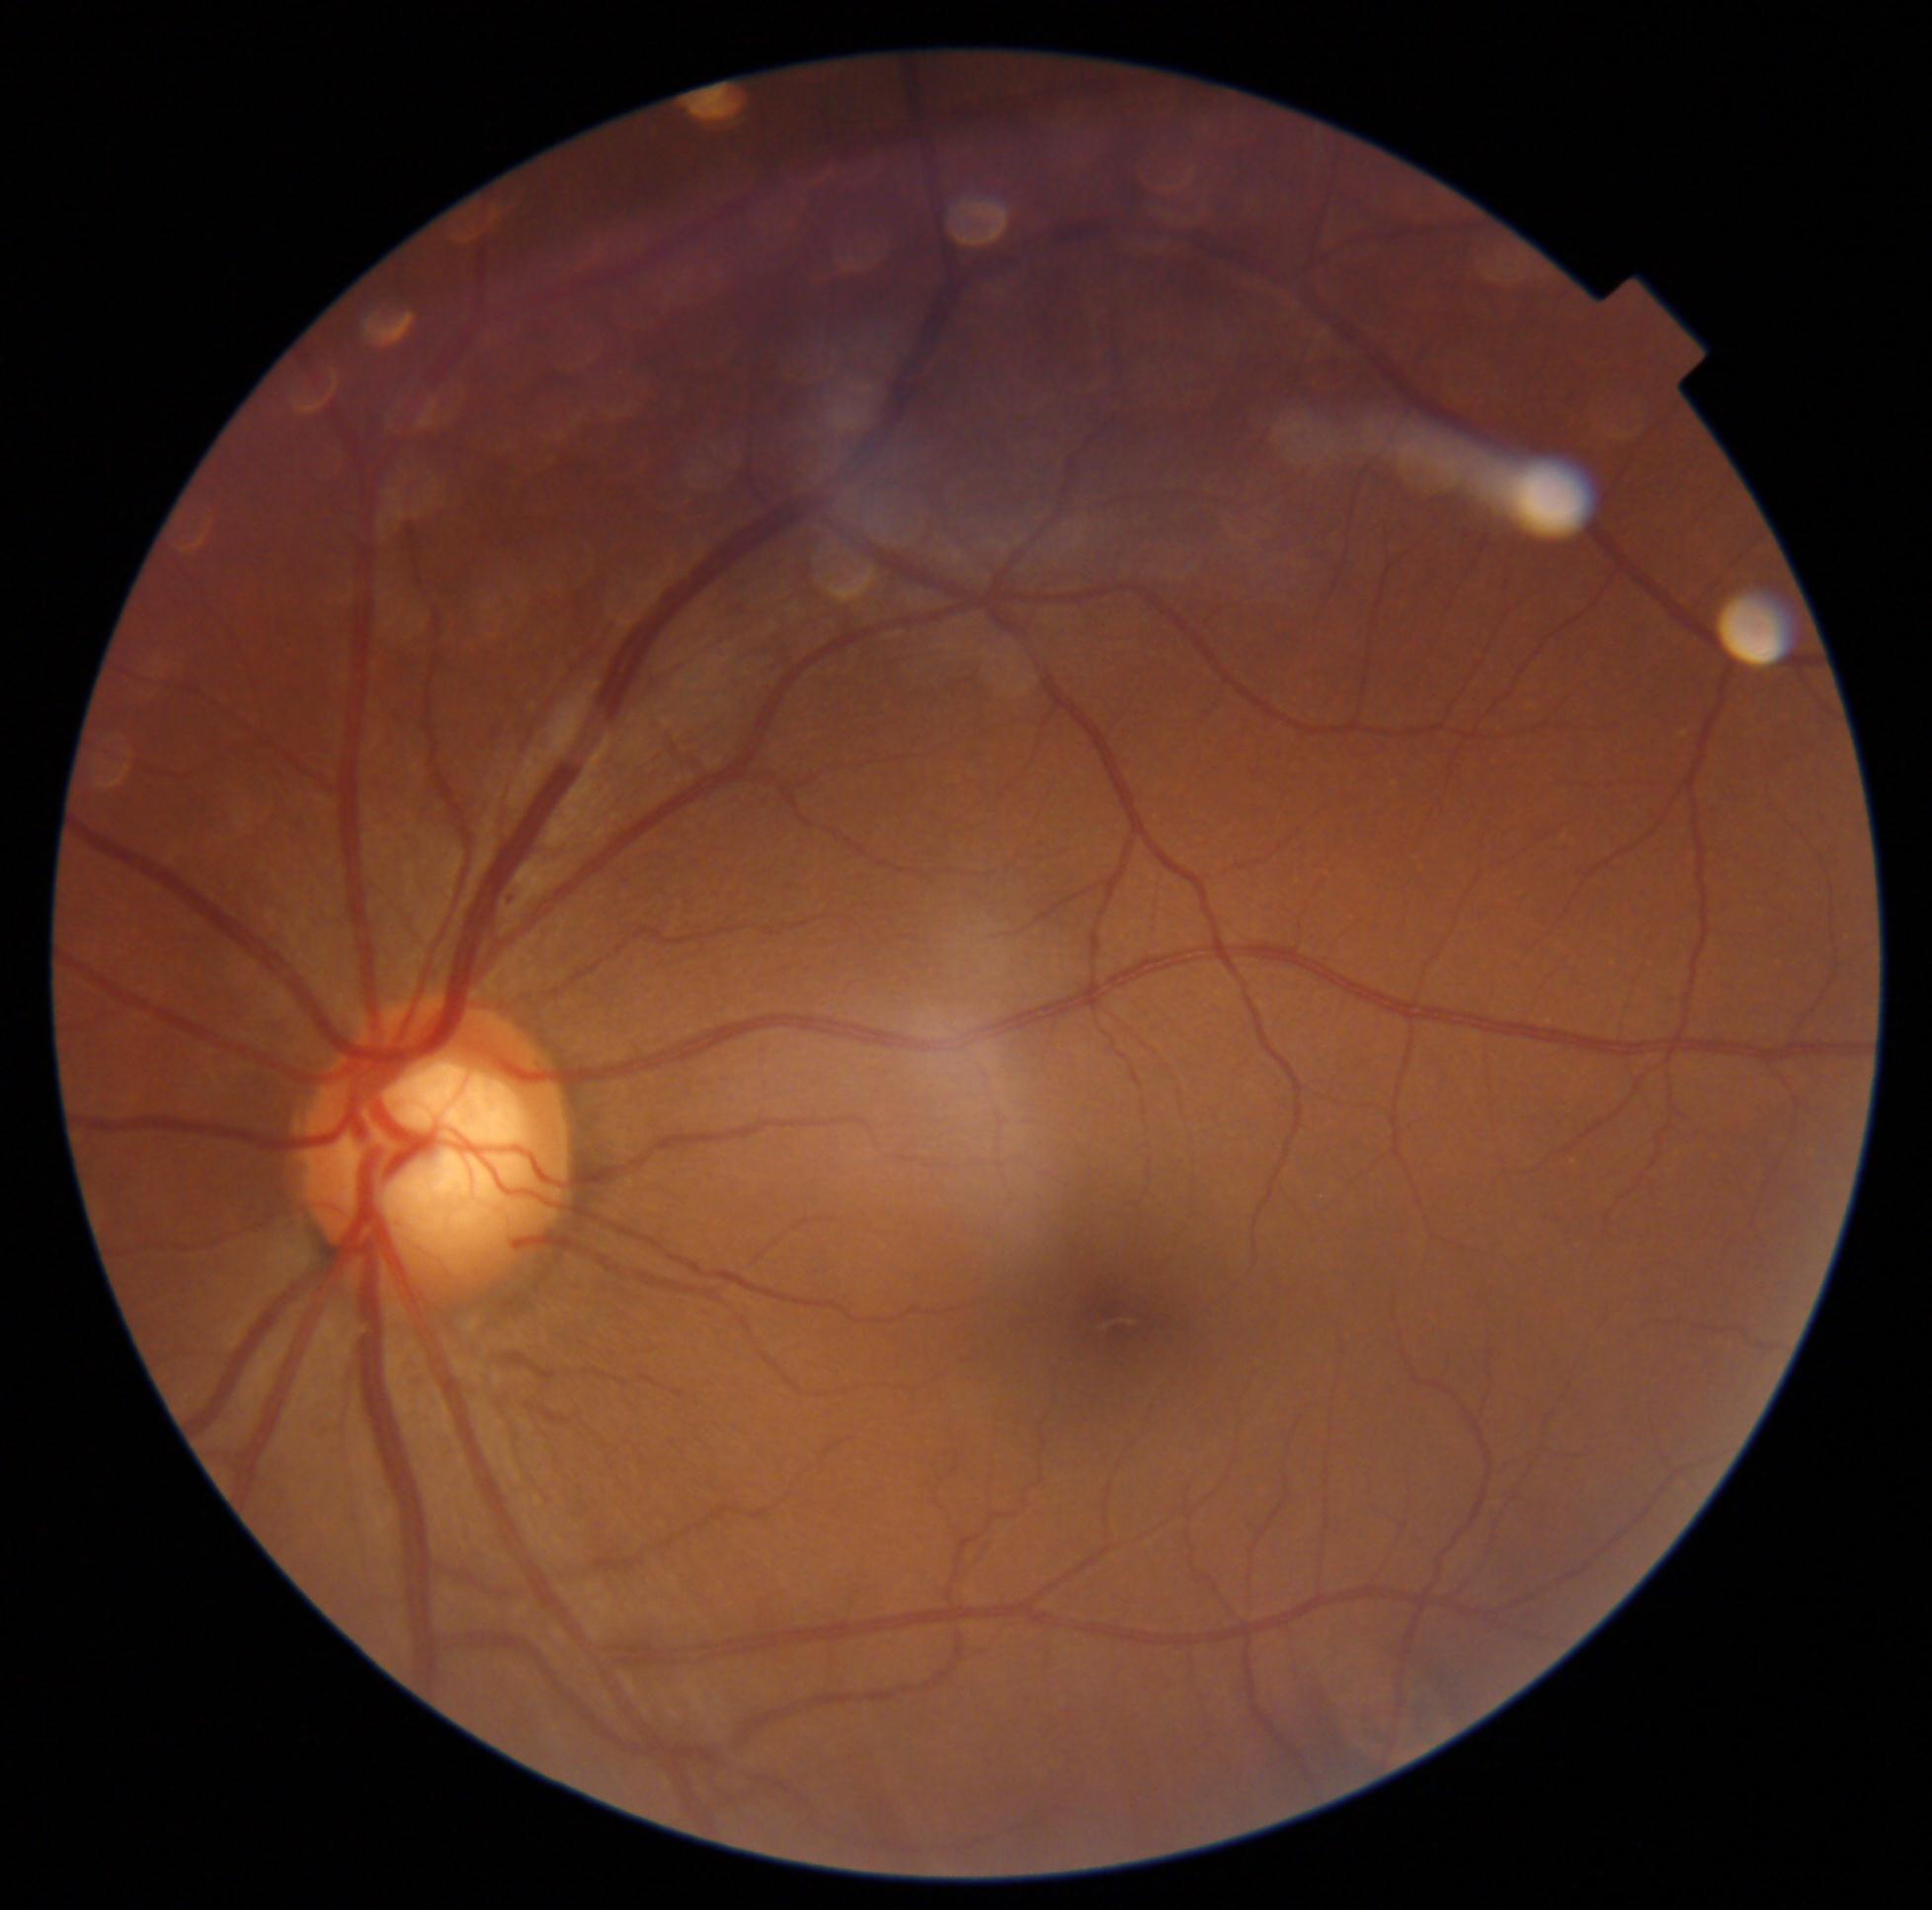
– diabetic retinopathy — 1 — presence of microaneurysms only